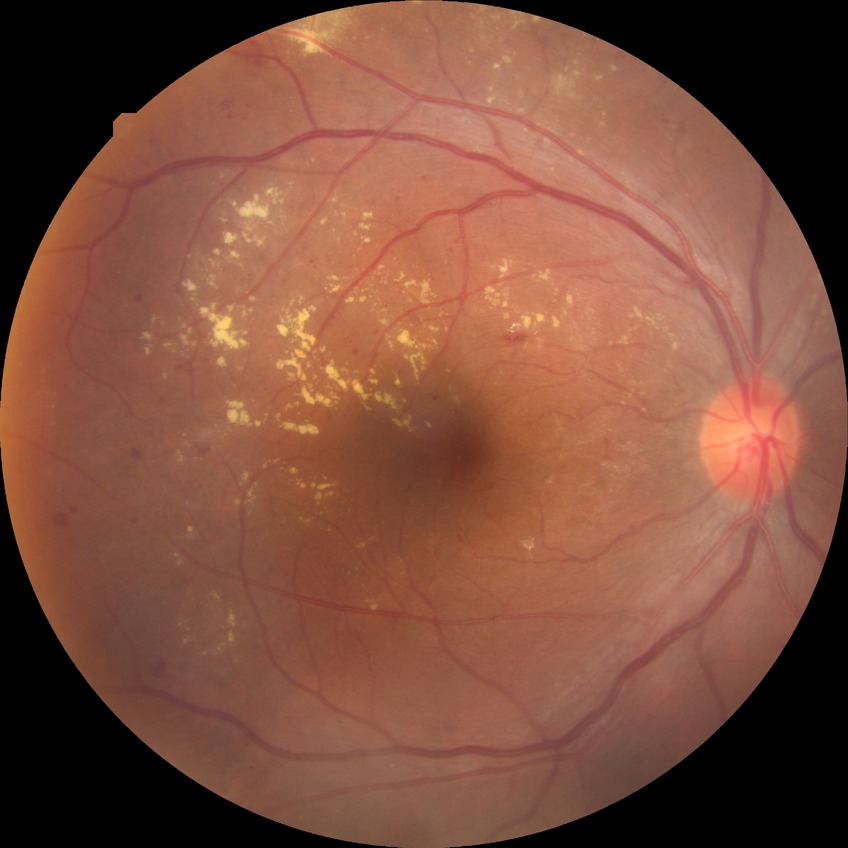 diabetic retinopathy (DR) = simple diabetic retinopathy (SDR).